Image size 848x848 · nonmydriatic · retinal fundus photograph — 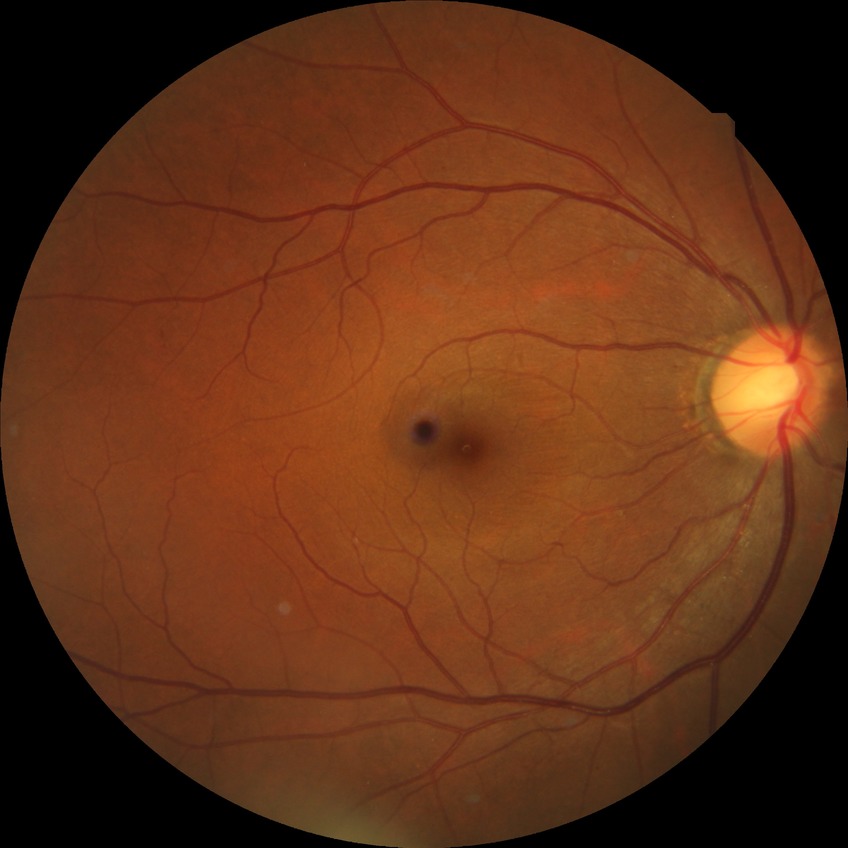 {
  "davis_grade": "simple diabetic retinopathy"
}